CFP, 1932 x 1916 pixels — 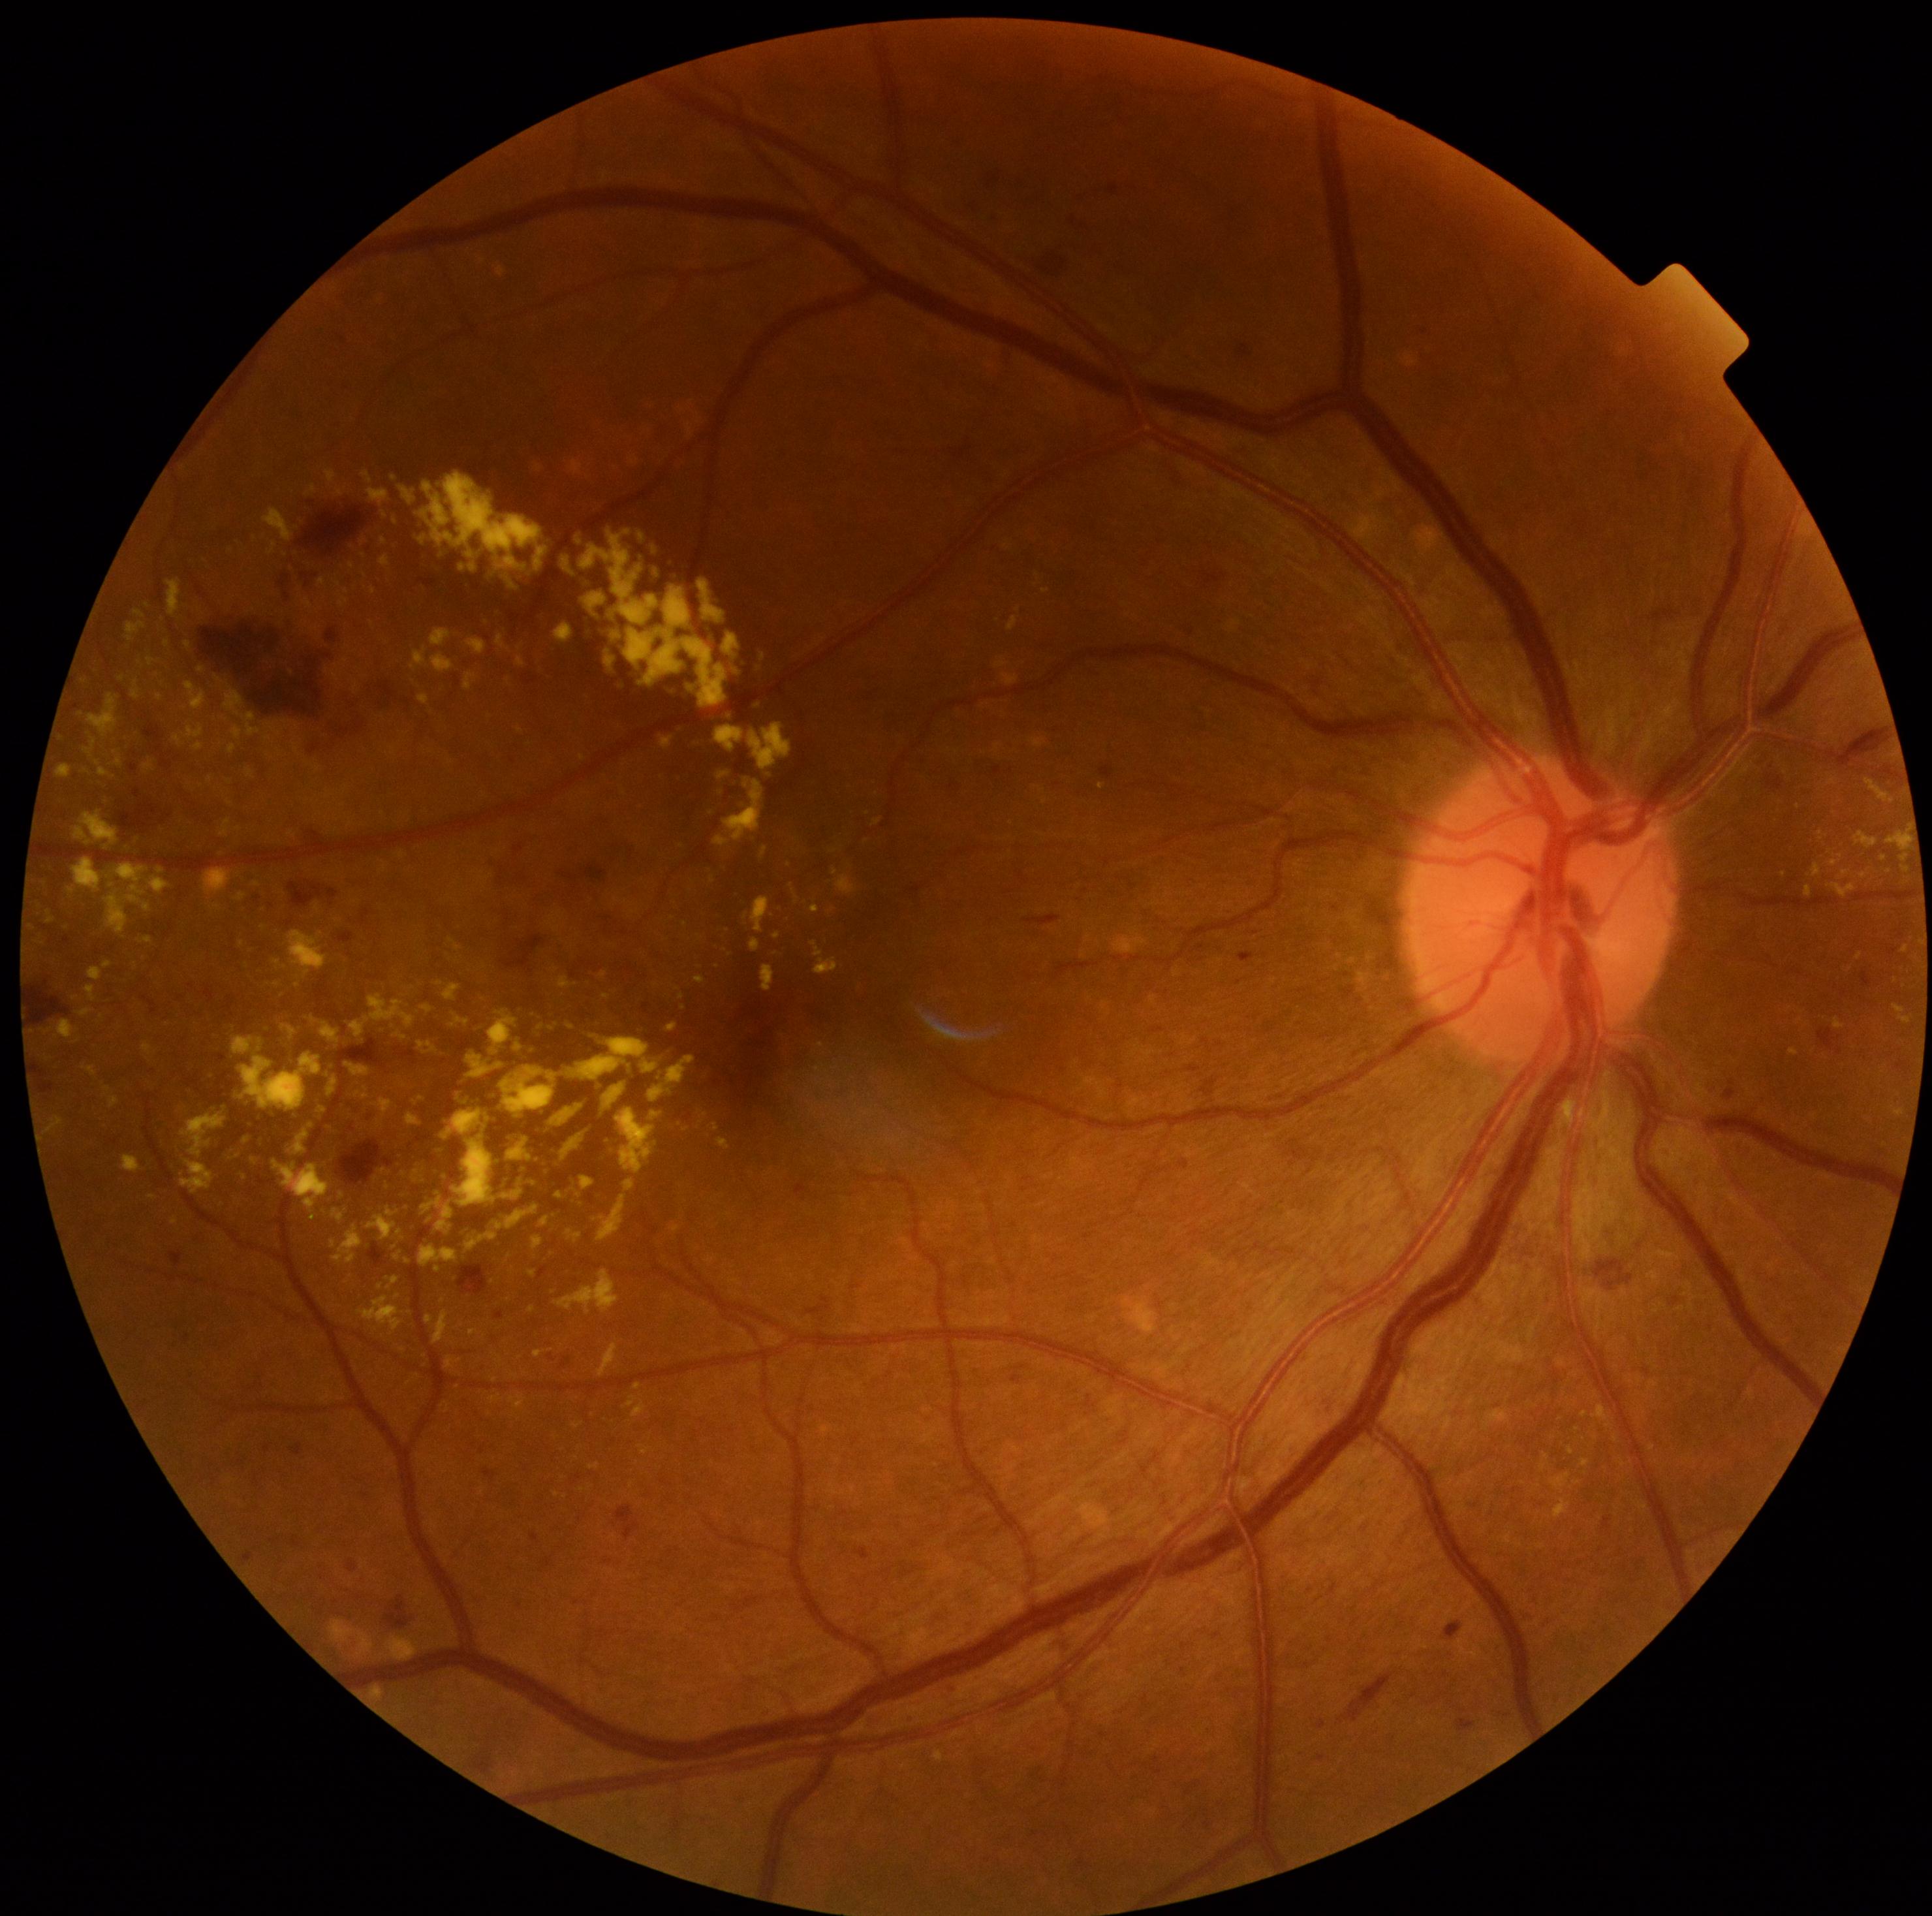

DR: 2 — more than just microaneurysms but less than severe NPDR
Representative lesions:
EXs (subset) = <box>873,820,882,825</box> | <box>599,1343,619,1377</box> | <box>272,960,287,969</box> | <box>541,1217,550,1229</box> | <box>767,1330,785,1347</box> | <box>1892,1004,1912,1025</box> | <box>377,1120,384,1129</box> | <box>730,1278,742,1283</box> | <box>82,1065,99,1077</box> | <box>143,760,155,773</box> | <box>74,811,119,851</box> | <box>516,658,525,667</box>
EXs (small, approximate centers) near x=298 y=985 | x=628 y=534 | x=385 y=514 | x=269 y=757 | x=423 y=540 | x=515 y=1376 | x=684 y=925